Pediatric wide-field fundus photograph. 100° field of view (Phoenix ICON).
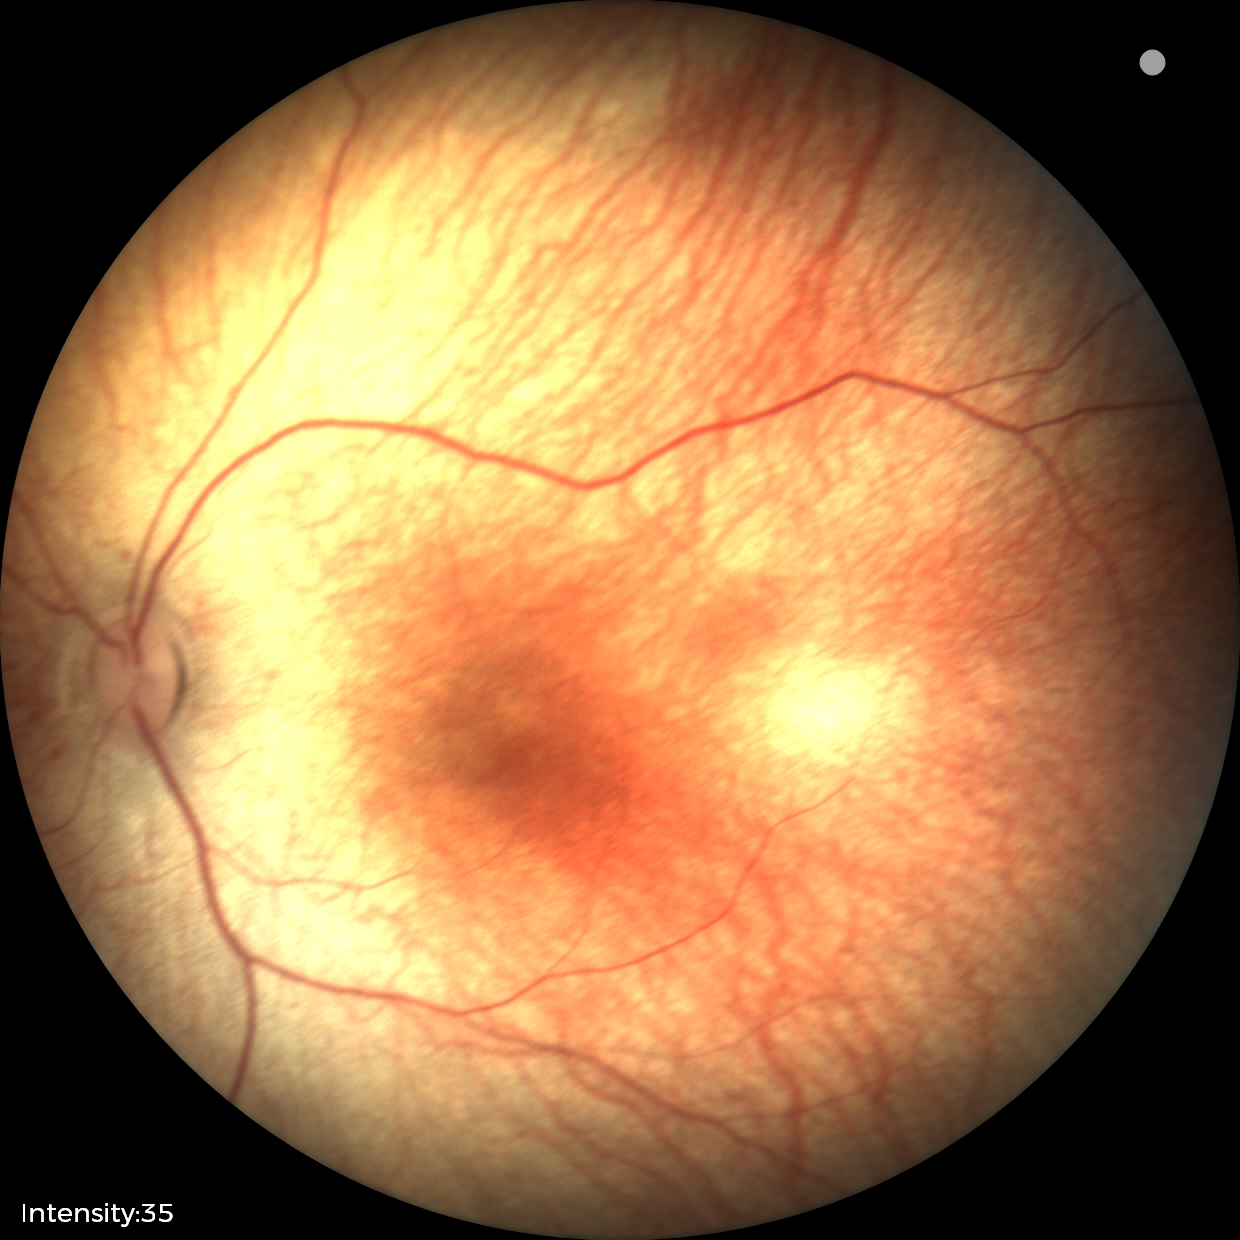 Finding = no pathology identified.